45° field of view. Image size 2352x1568. Retinal fundus photograph:
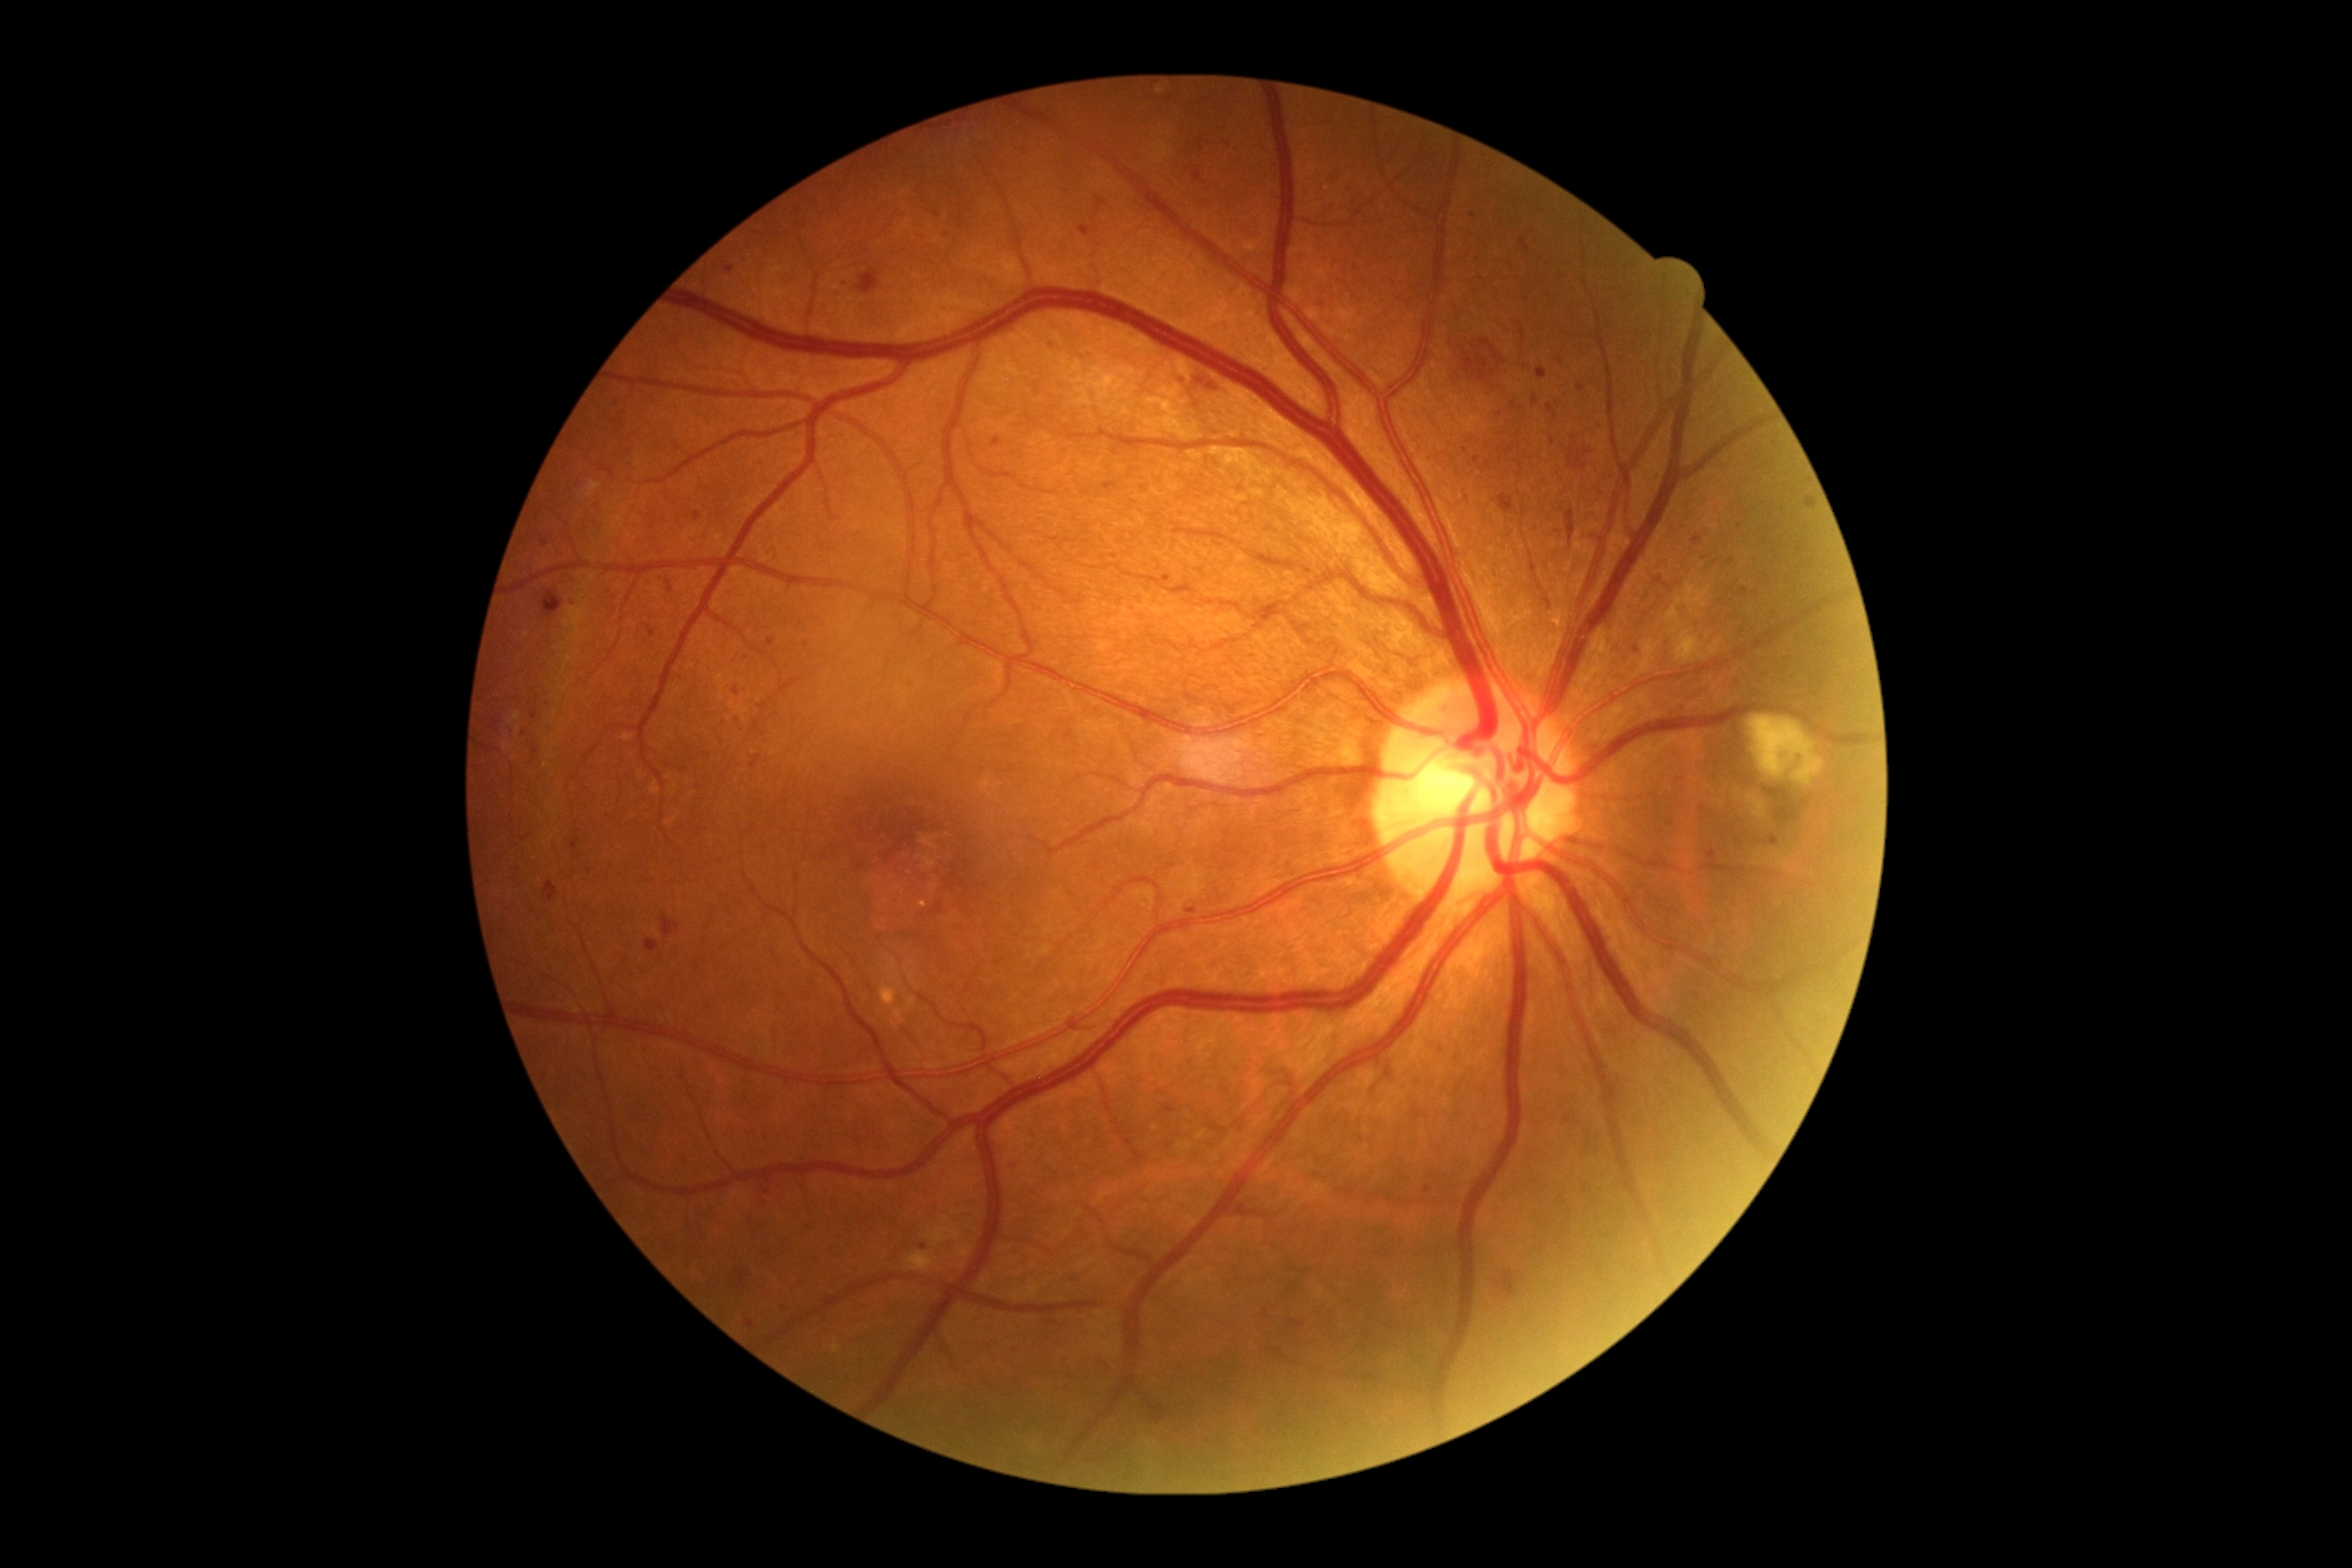 {
  "dr_grade": "grade 2 (moderate NPDR) — more than just microaneurysms but less than severe NPDR"
}